Without pupil dilation
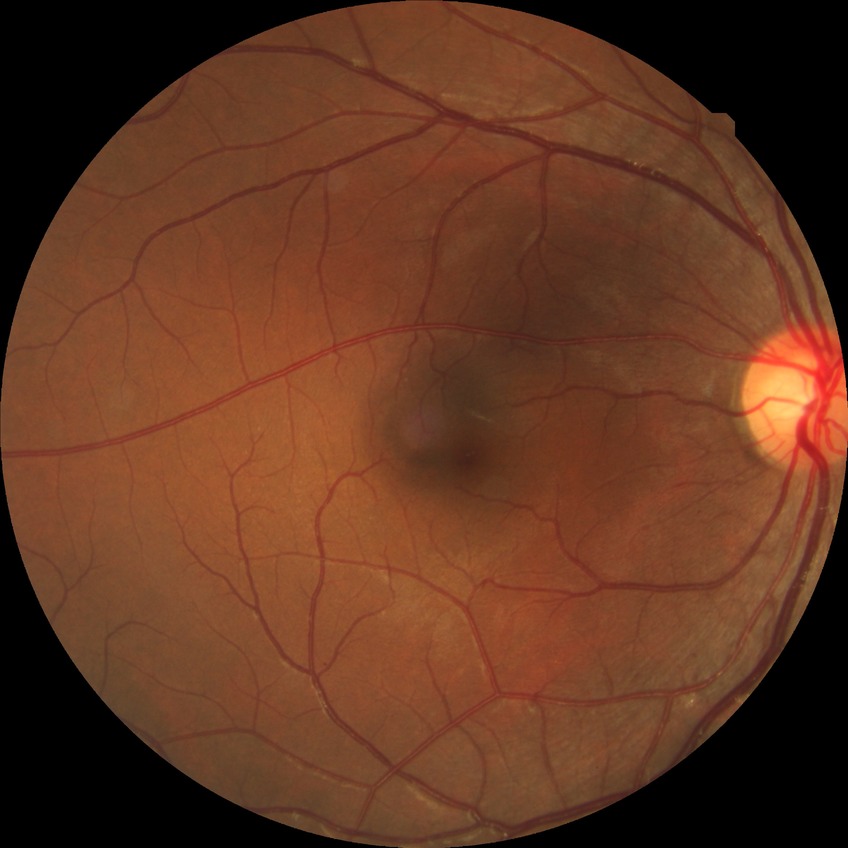 diabetic retinopathy (DR)=no diabetic retinopathy (NDR).